1920x1440px:
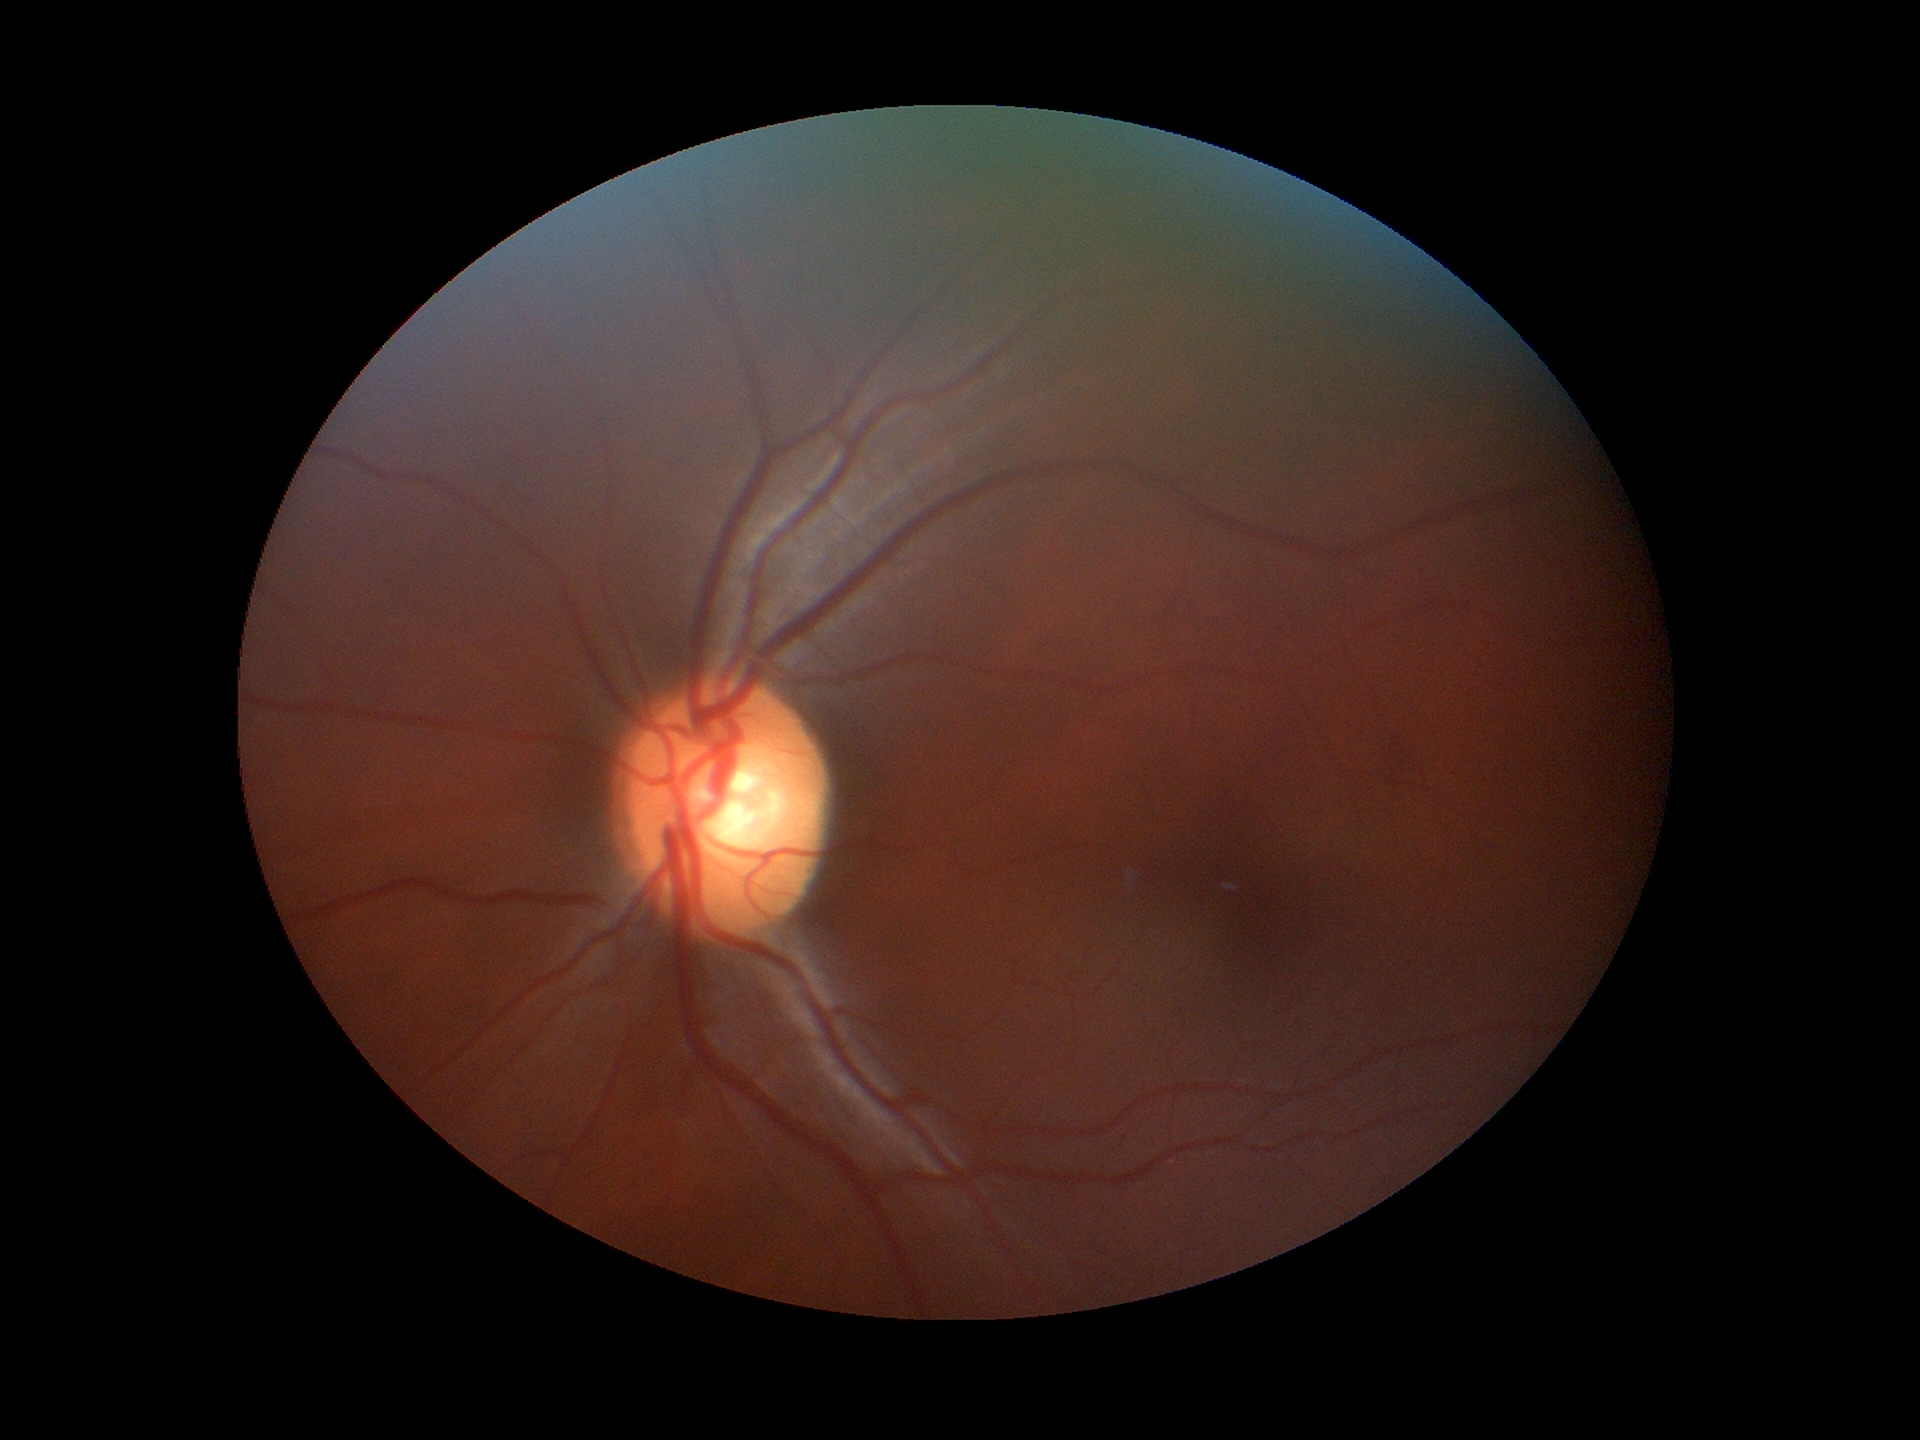
Glaucoma impression = no suspicious findings
vertical cup-disc ratio (VCDR) = 0.52
horizontal C/D ratio (HCDR) = 0.58